Captured after pupil dilation. Topcon TRC-50DX. 50° field of view
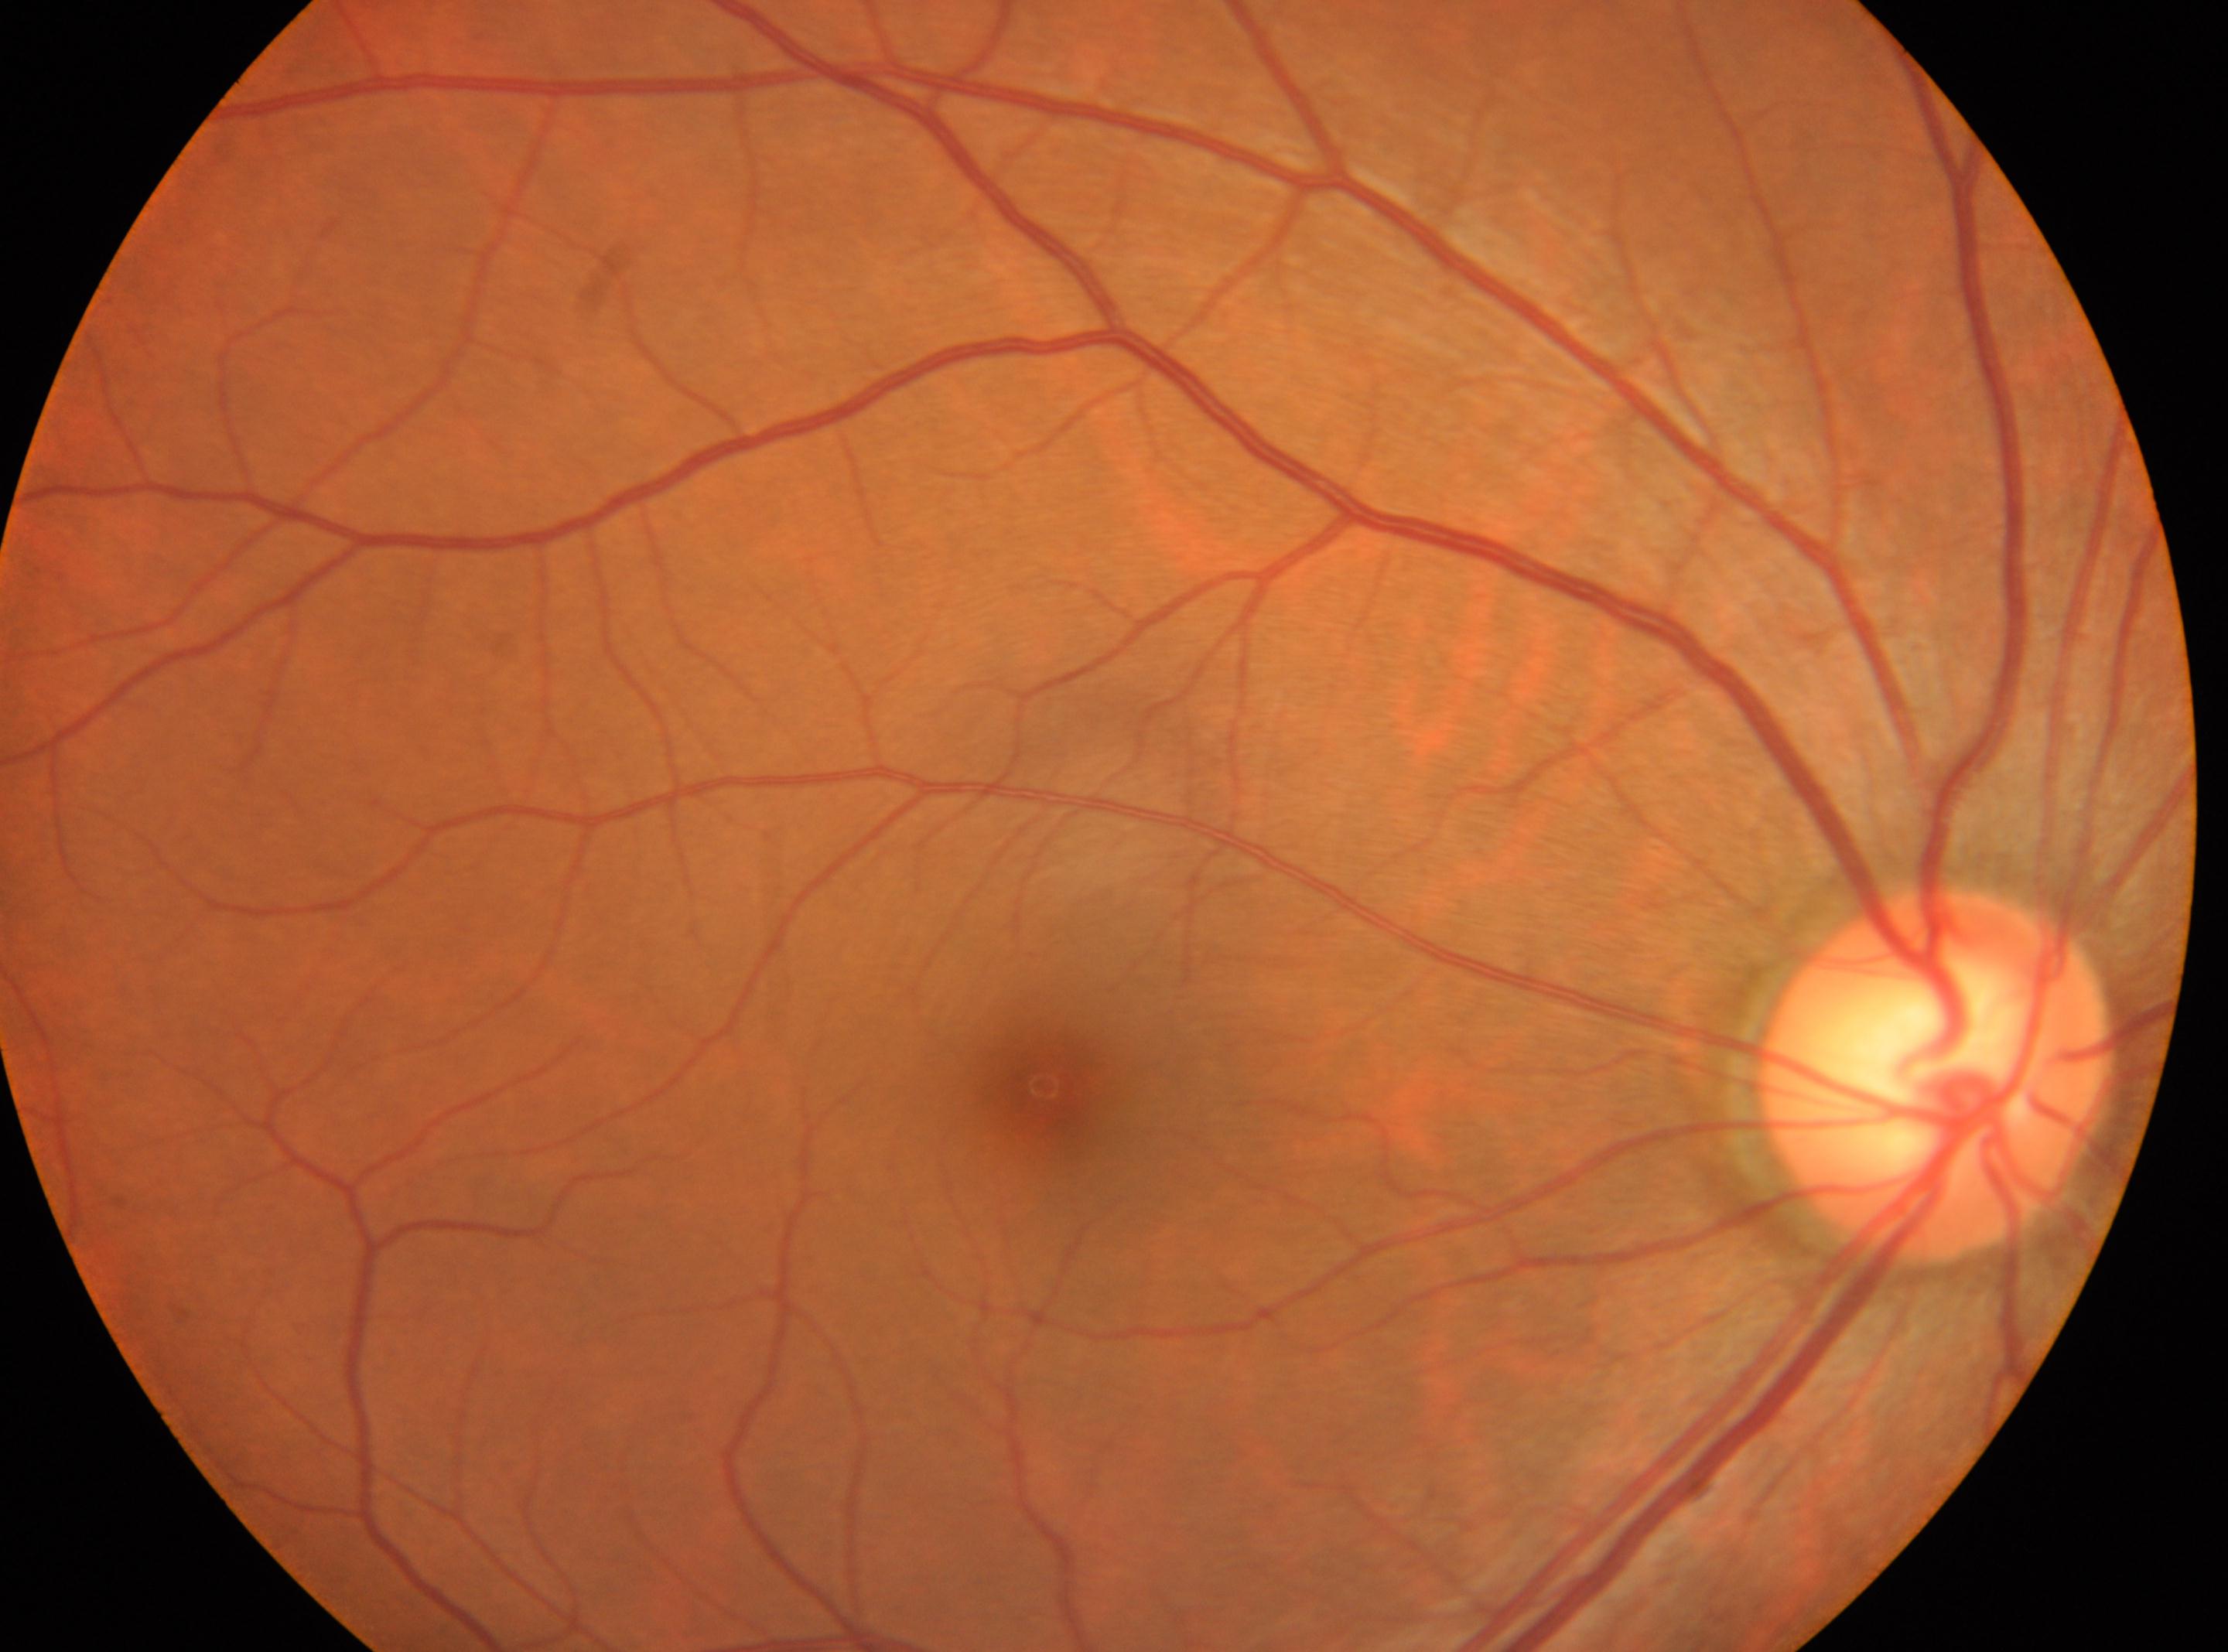 optic disc: (1937, 1071) | macular center: (1043, 1084) | laterality: oculus dexter | diabetic retinopathy (DR): 0 — no visible signs of diabetic retinopathy.